Without pupil dilation: 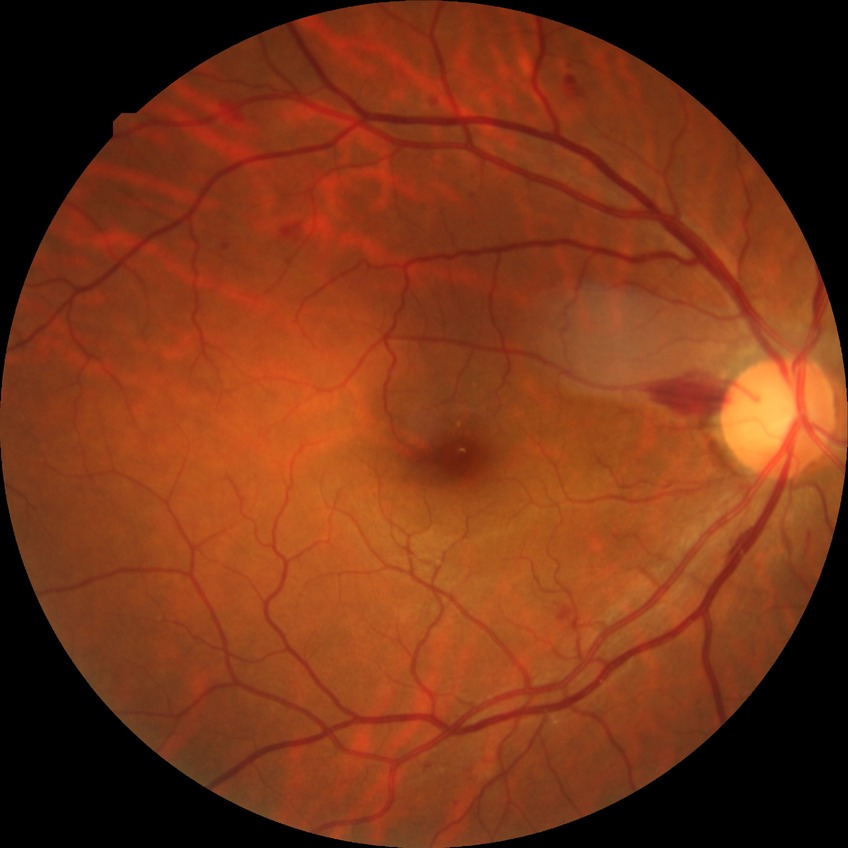
modified Davis classification@simple diabetic retinopathy, DR class@non-proliferative diabetic retinopathy.